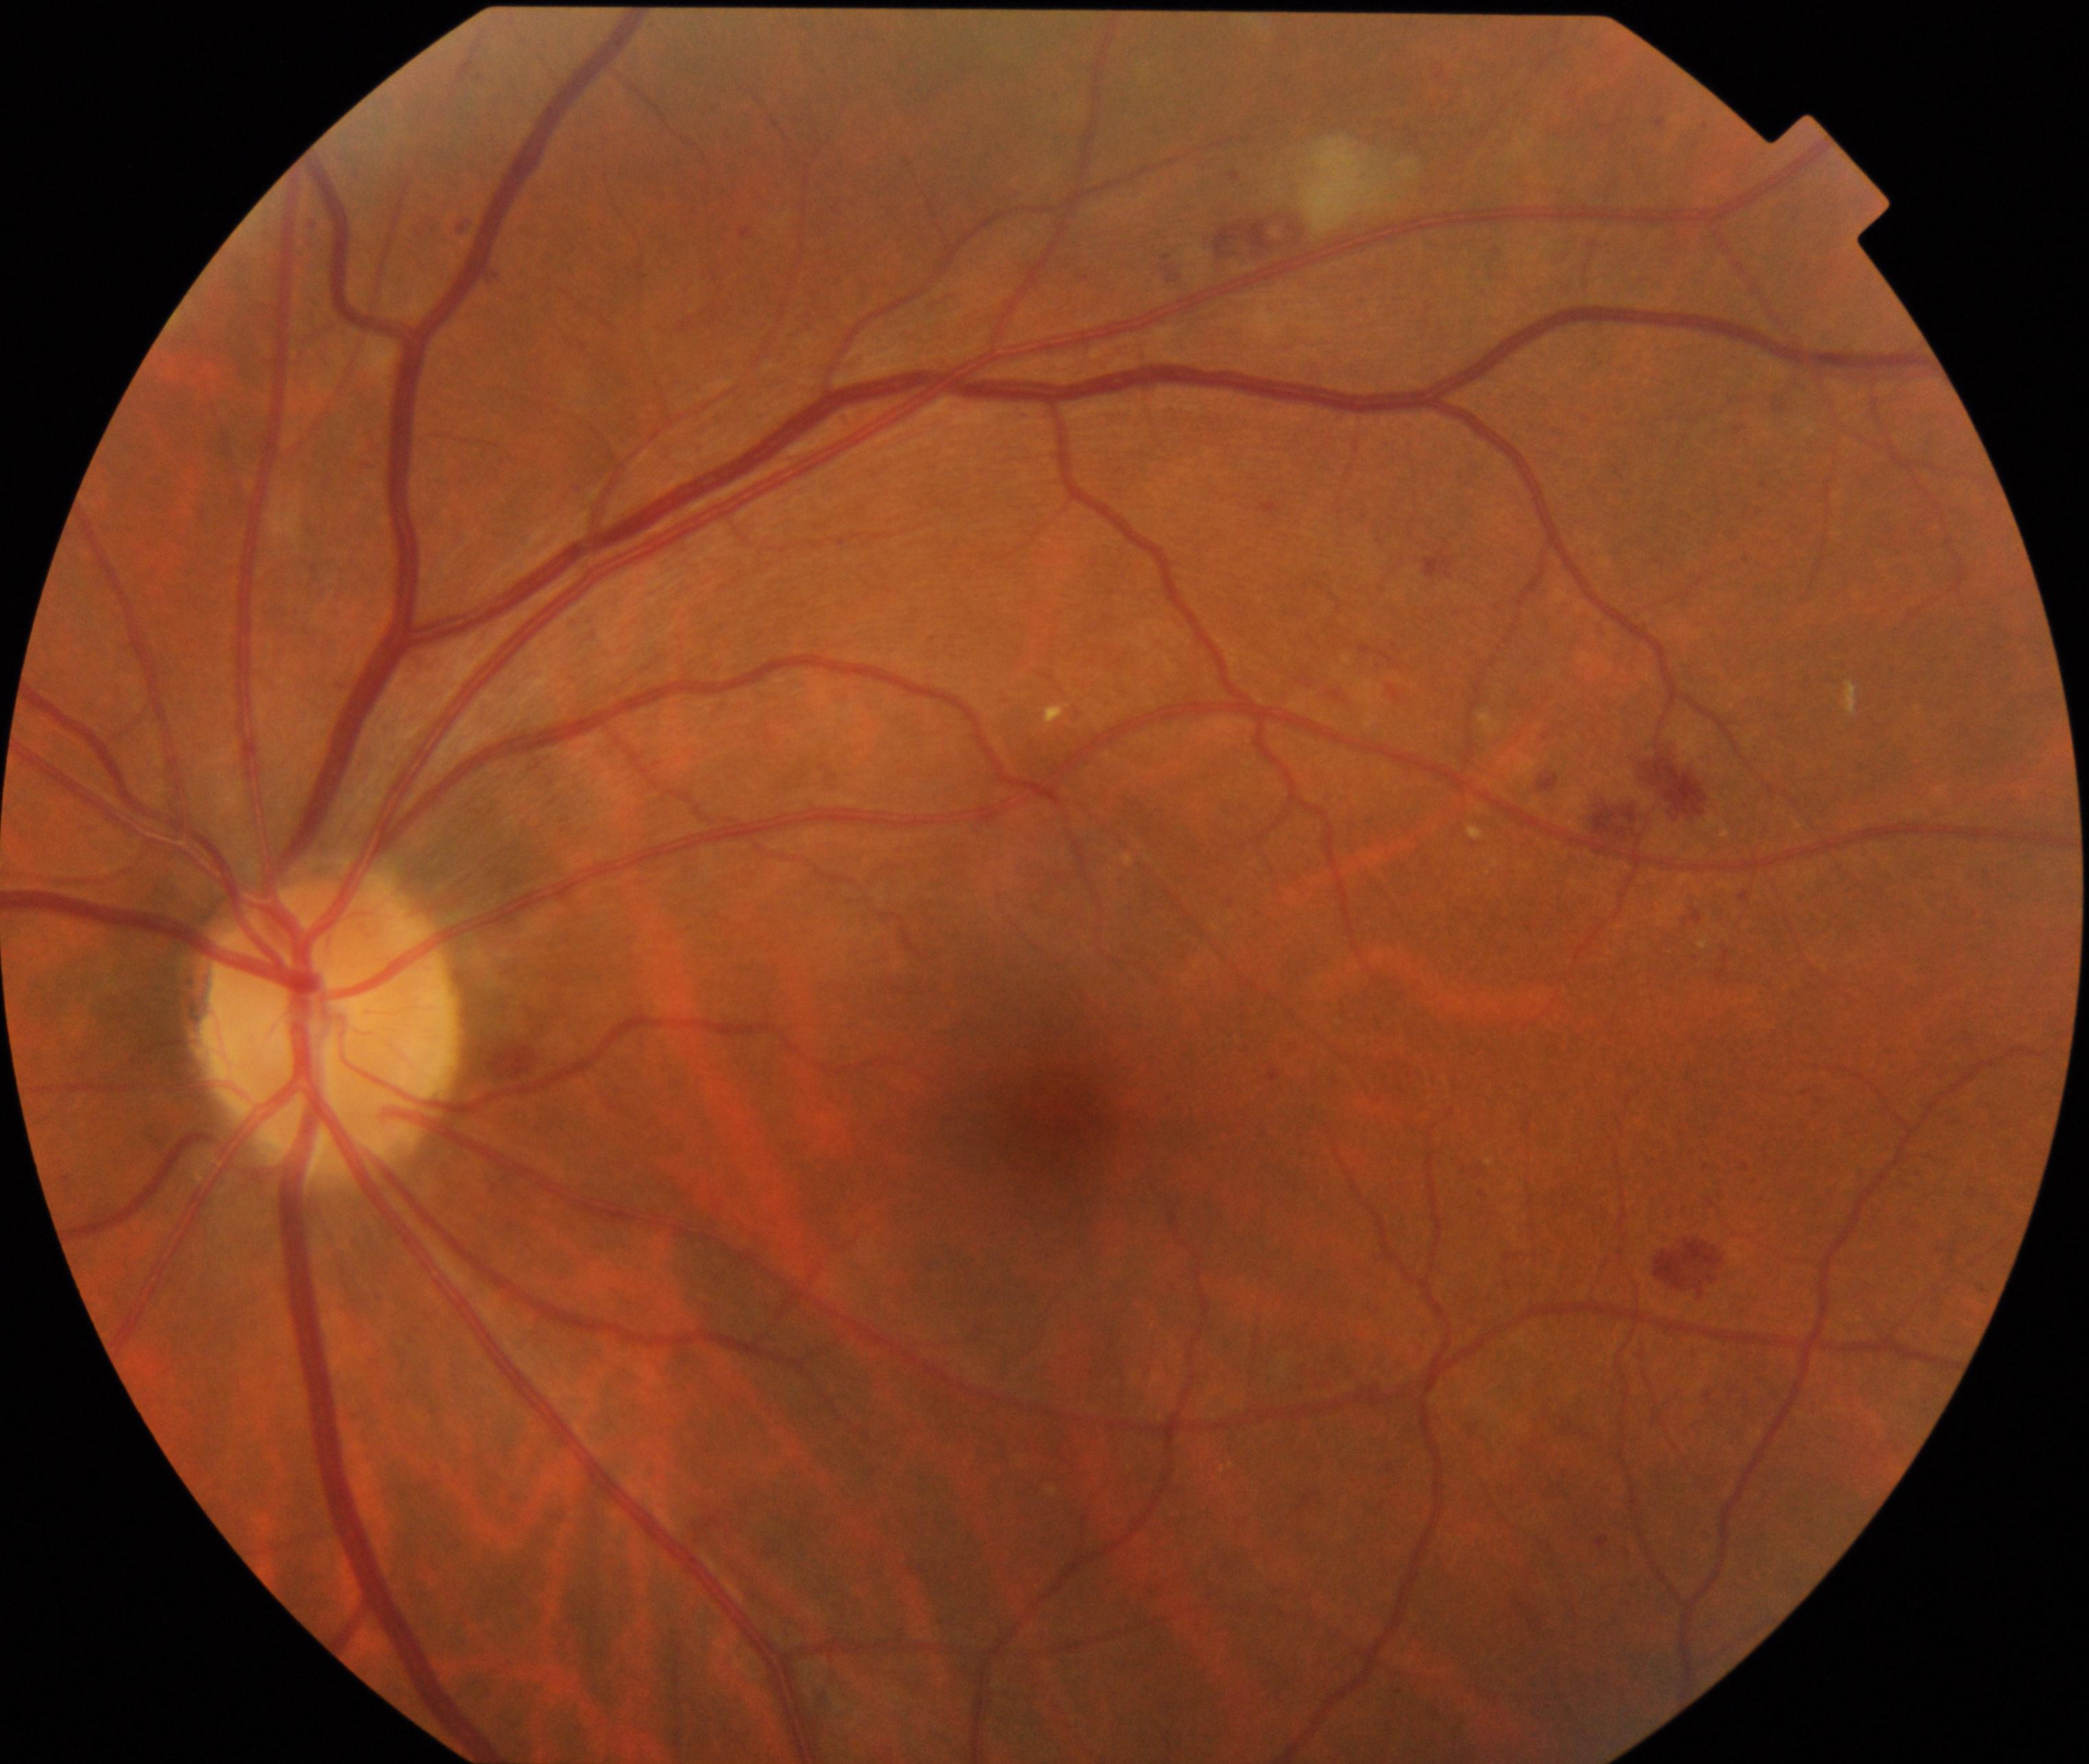 Fundus appearance consistent with moderate non-proliferative diabetic retinopathy. Features include microaneurysms with dot and blot hemorrhages or hard exudates, less than severe non-proliferative diabetic retinopathy, and/or with diabetic macular edema.